Retinal fundus photograph, 2352x1568, FOV: 45 degrees:
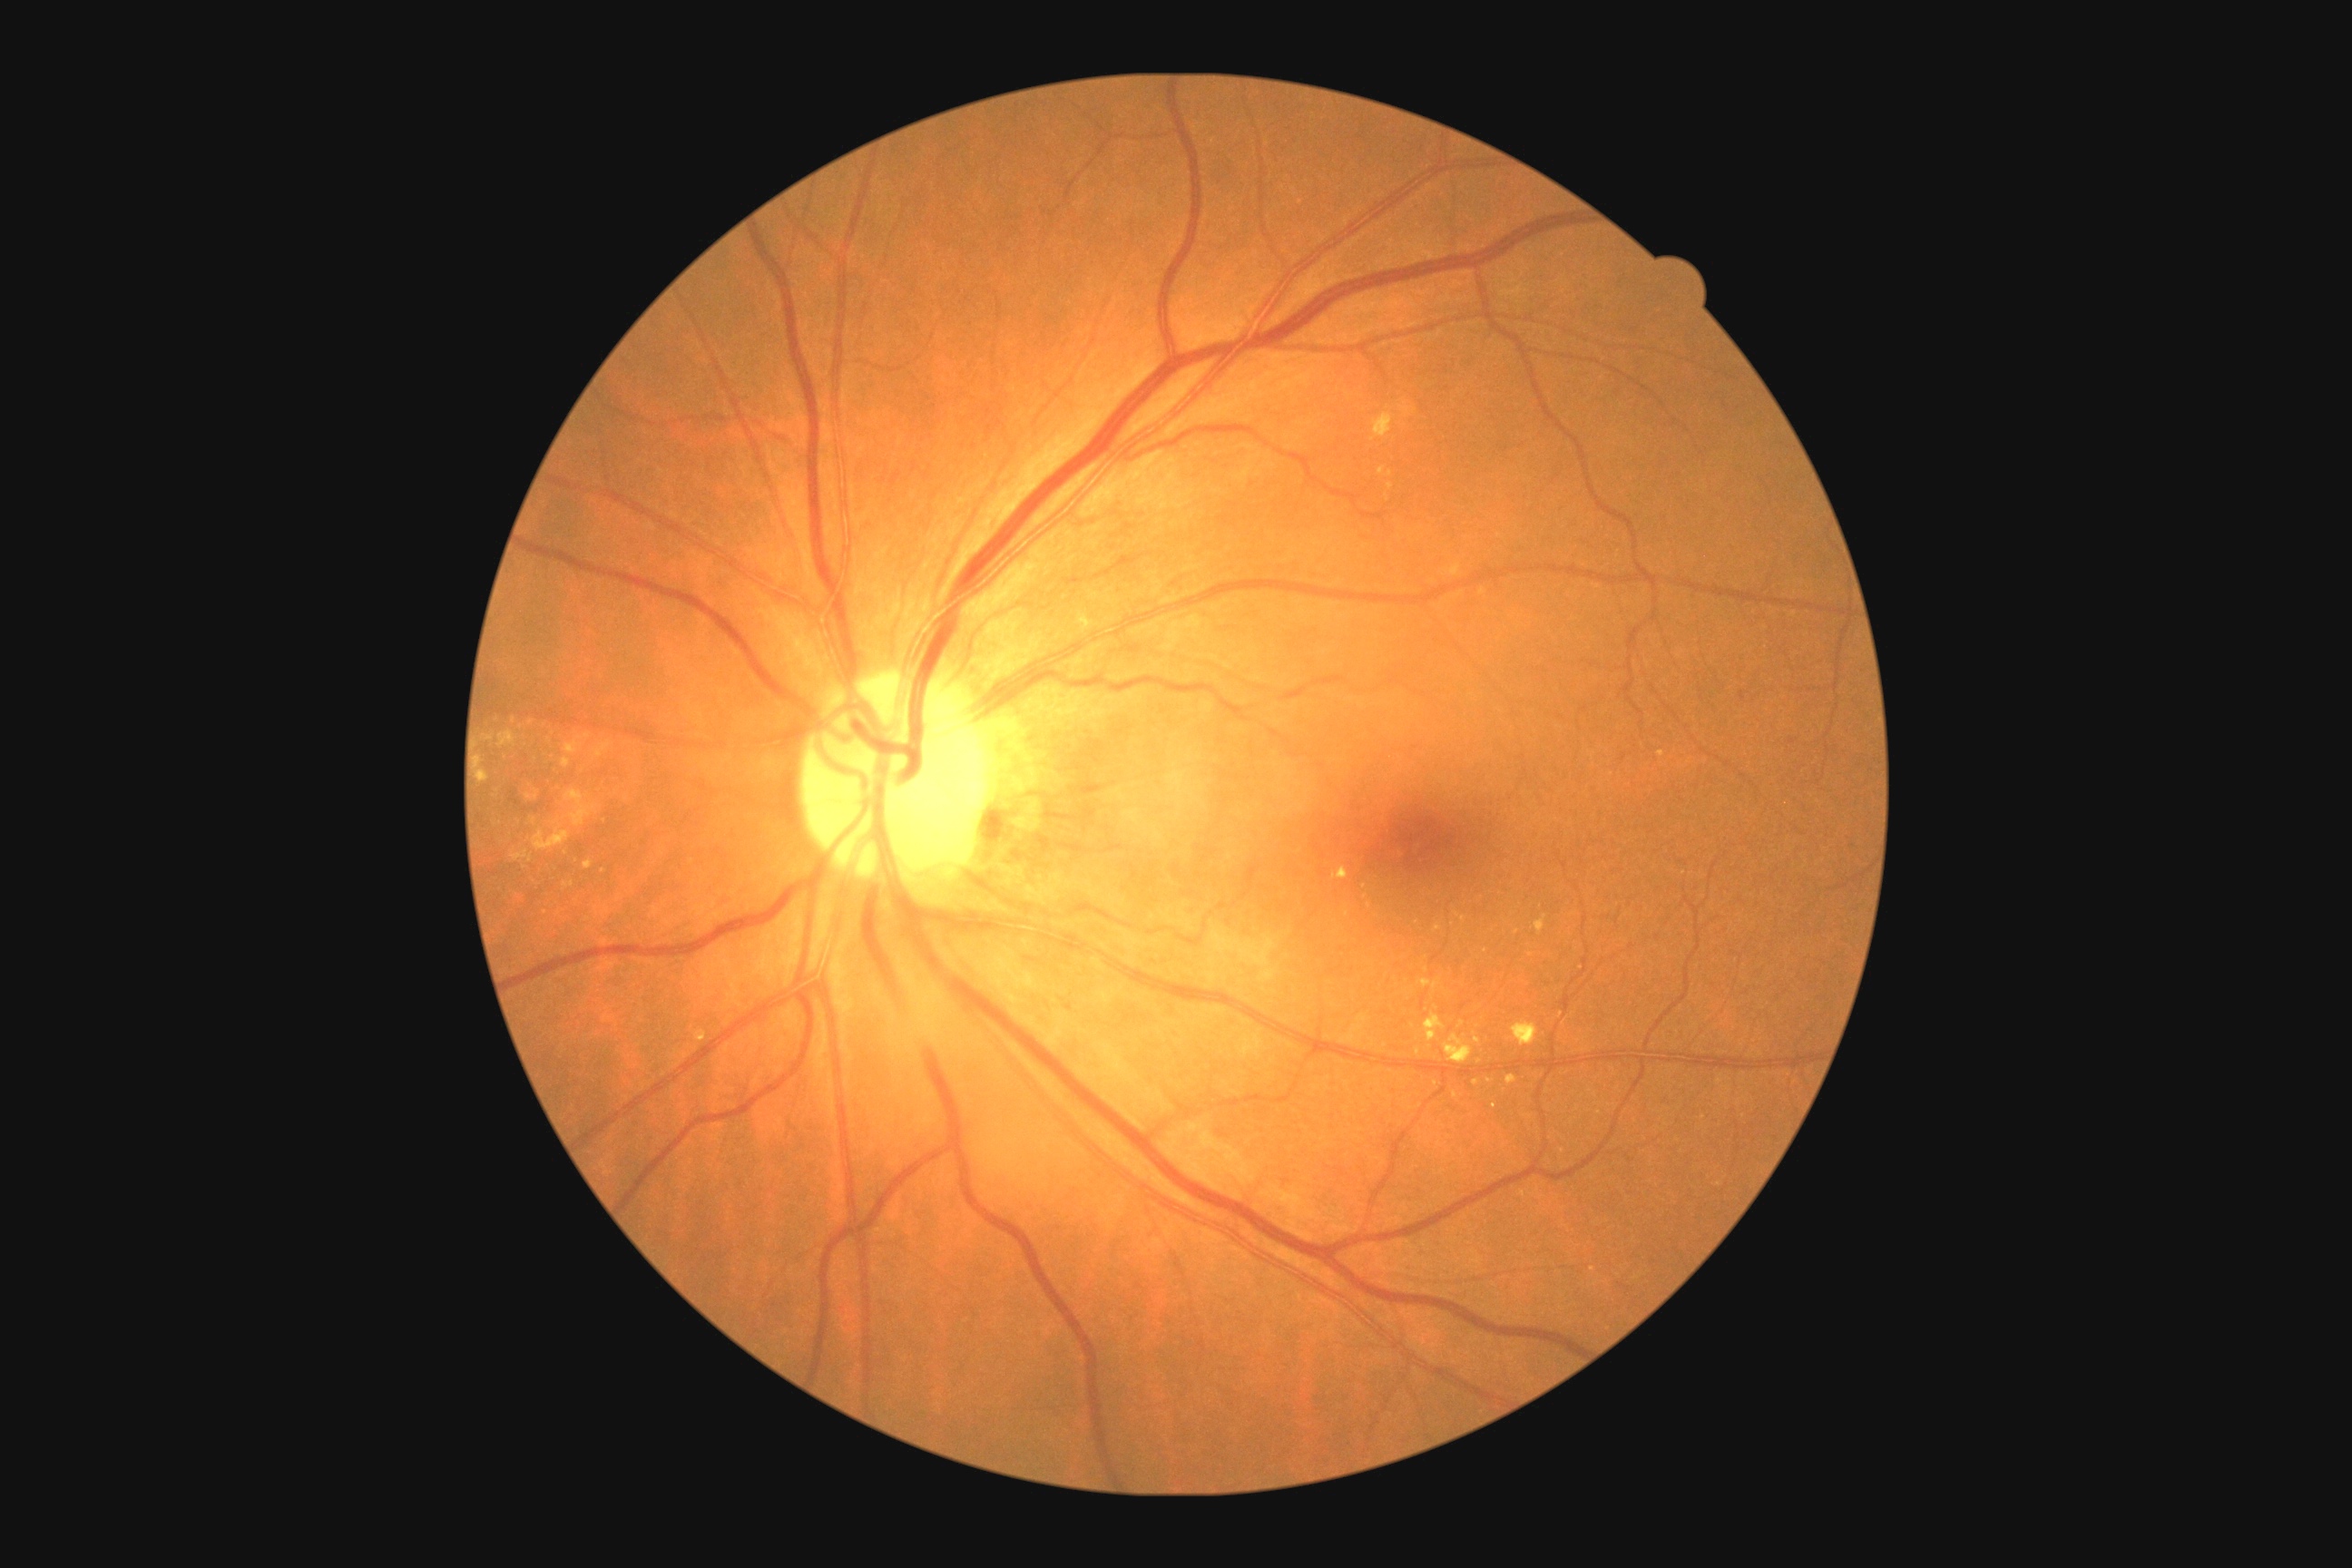
Diabetic retinopathy grade: 2/4
Representative lesions:
hard exudates (subset): <box>525,790,540,801</box>; <box>1424,1014,1446,1043</box>; <box>1418,979,1442,990</box>; <box>603,906,611,914</box>; <box>480,770,489,783</box>; <box>562,760,571,769</box>; <box>1444,1035,1473,1064</box>; <box>1453,1092,1458,1101</box>; <box>1079,614,1097,632</box>
Small hard exudates approximately at <pt>1369,906</pt>; <pt>514,720</pt>; <pt>545,912</pt>; <pt>1494,1107</pt>; <pt>1485,952</pt>; <pt>1436,1008</pt>; <pt>1461,1025</pt>; <pt>490,738</pt>; <pt>627,798</pt>